Color fundus image — 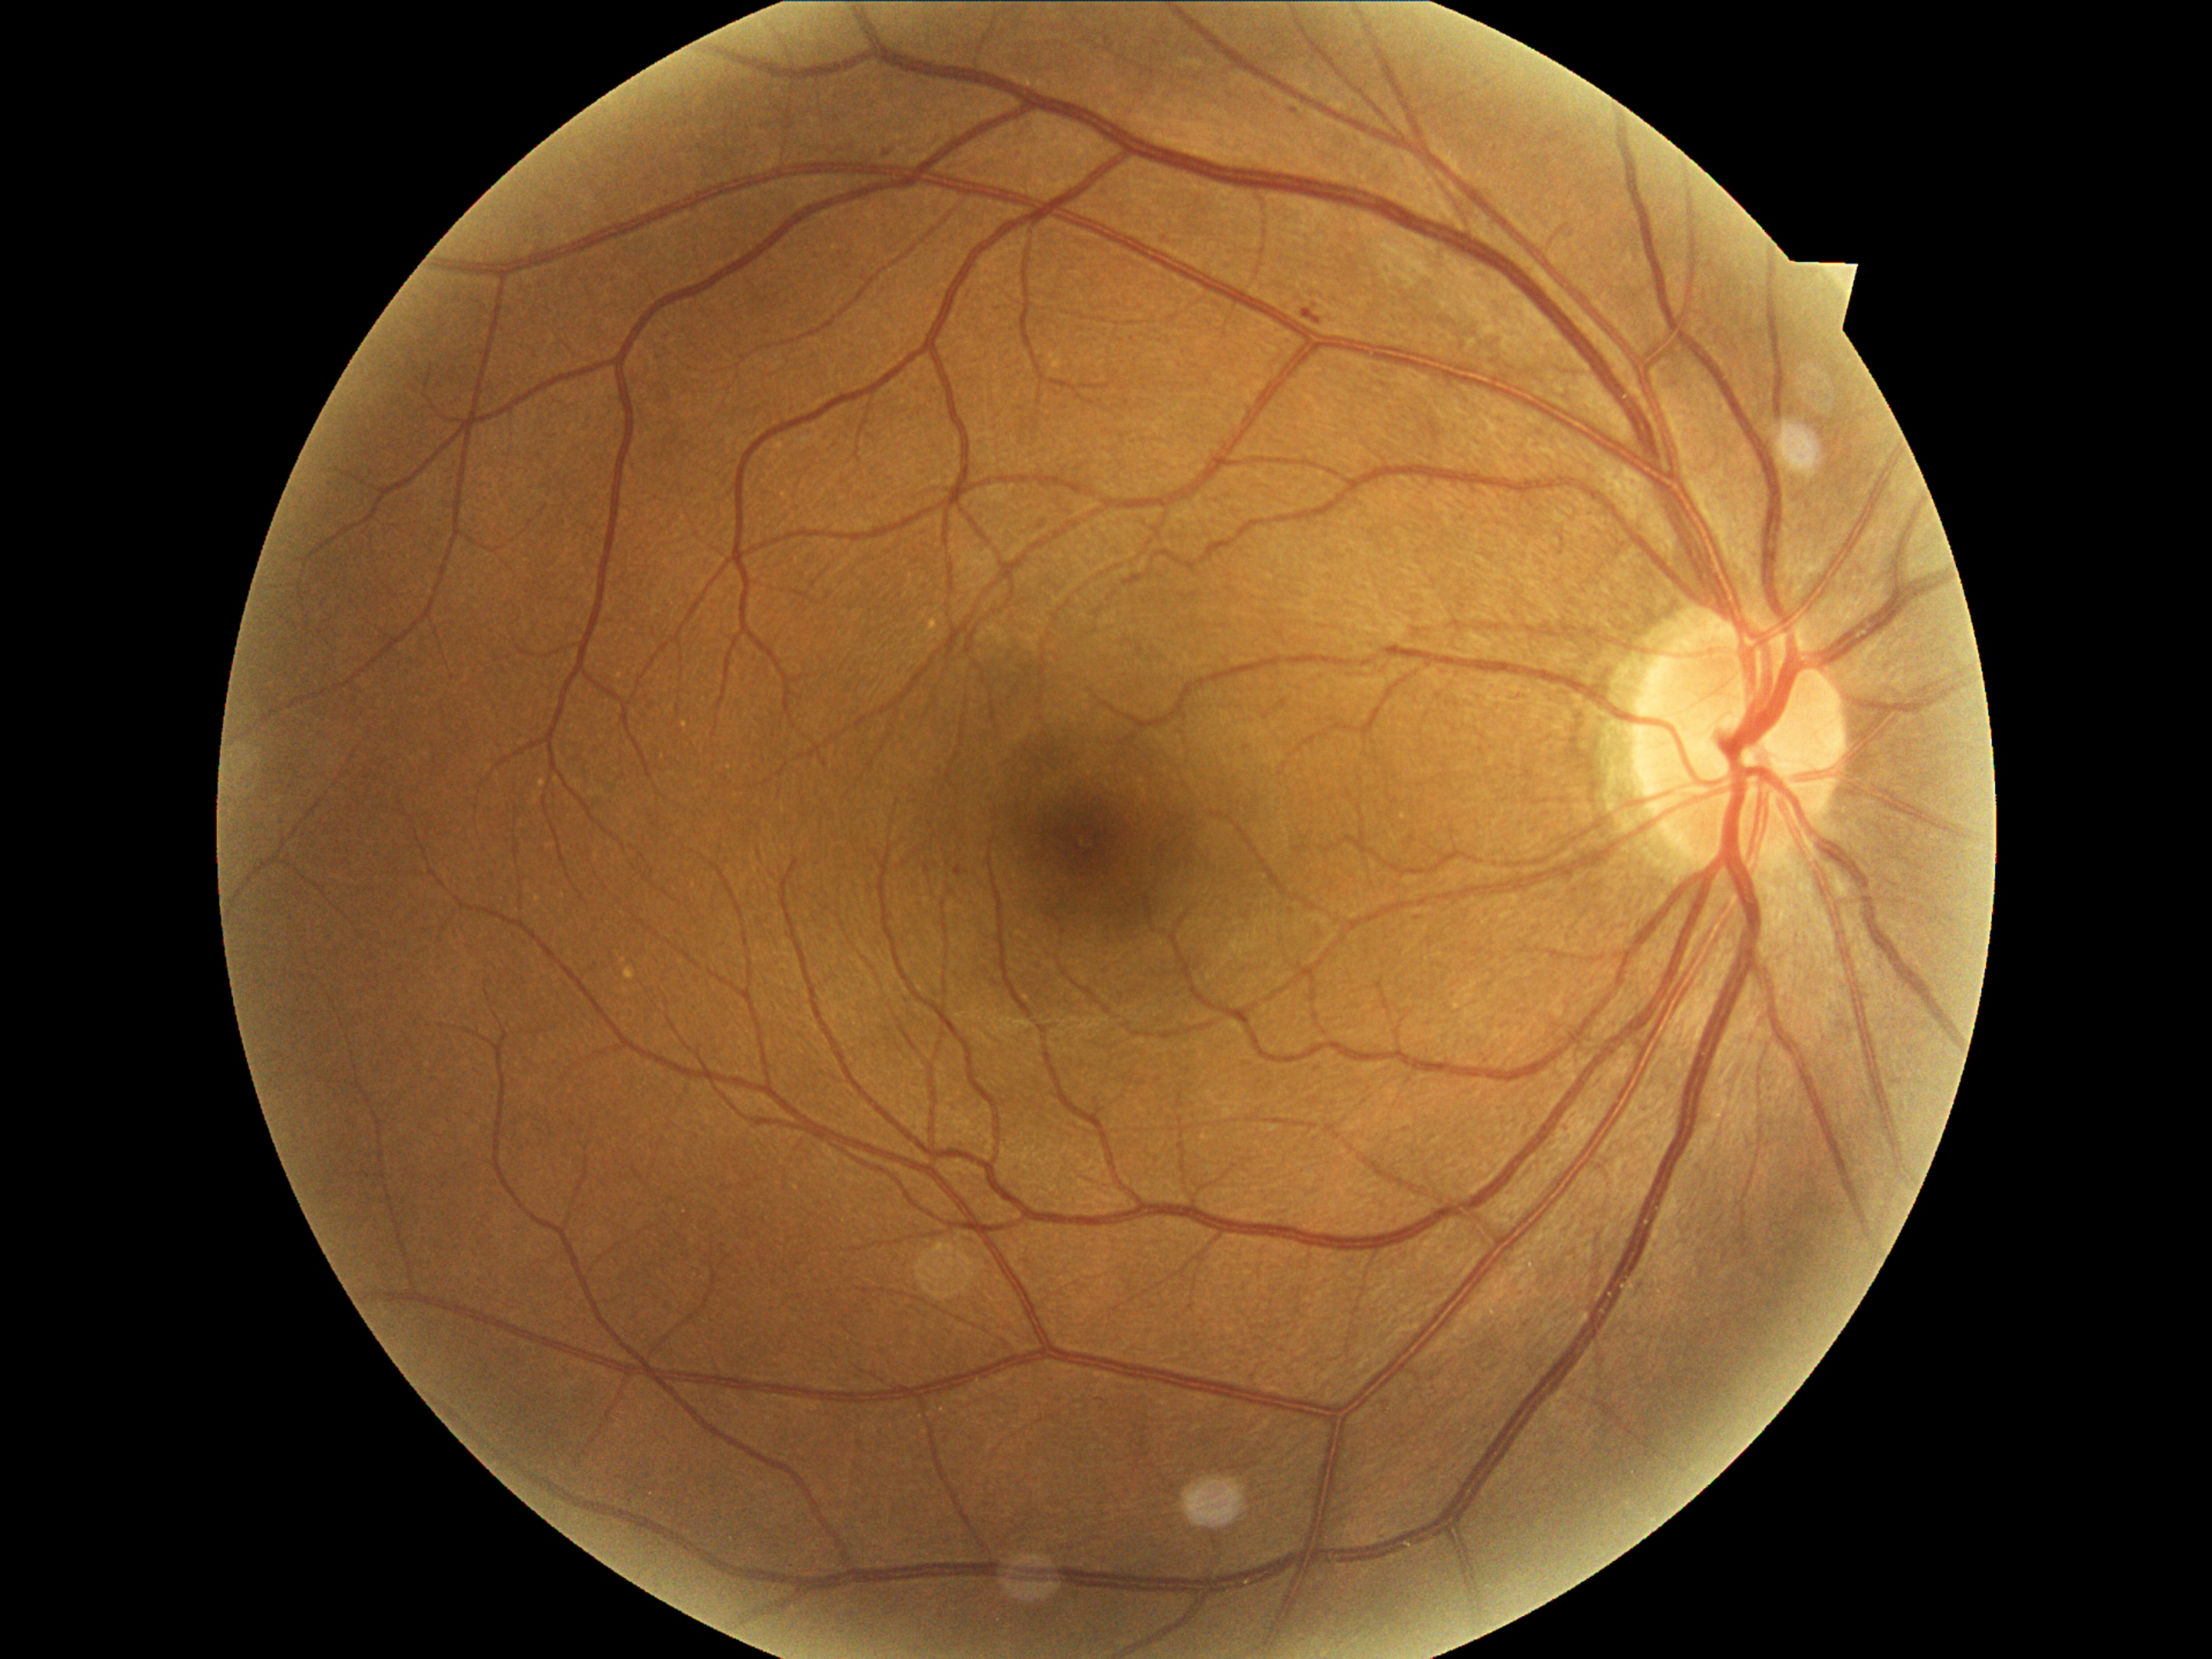
<lesions>
  <dr_grade>1</dr_grade>
  <ma>left=955, top=866, right=963, bottom=876 | left=1303, top=308, right=1322, bottom=325</ma>
  <ma_small_centers>887, 155 | 1294, 112 | 1417, 920</ma_small_centers>
  <se />
  <ex />
  <he />
</lesions>